Ultra-widefield (UWF) fundus image; FOV: 200 degrees; 1924 by 1556 pixels:
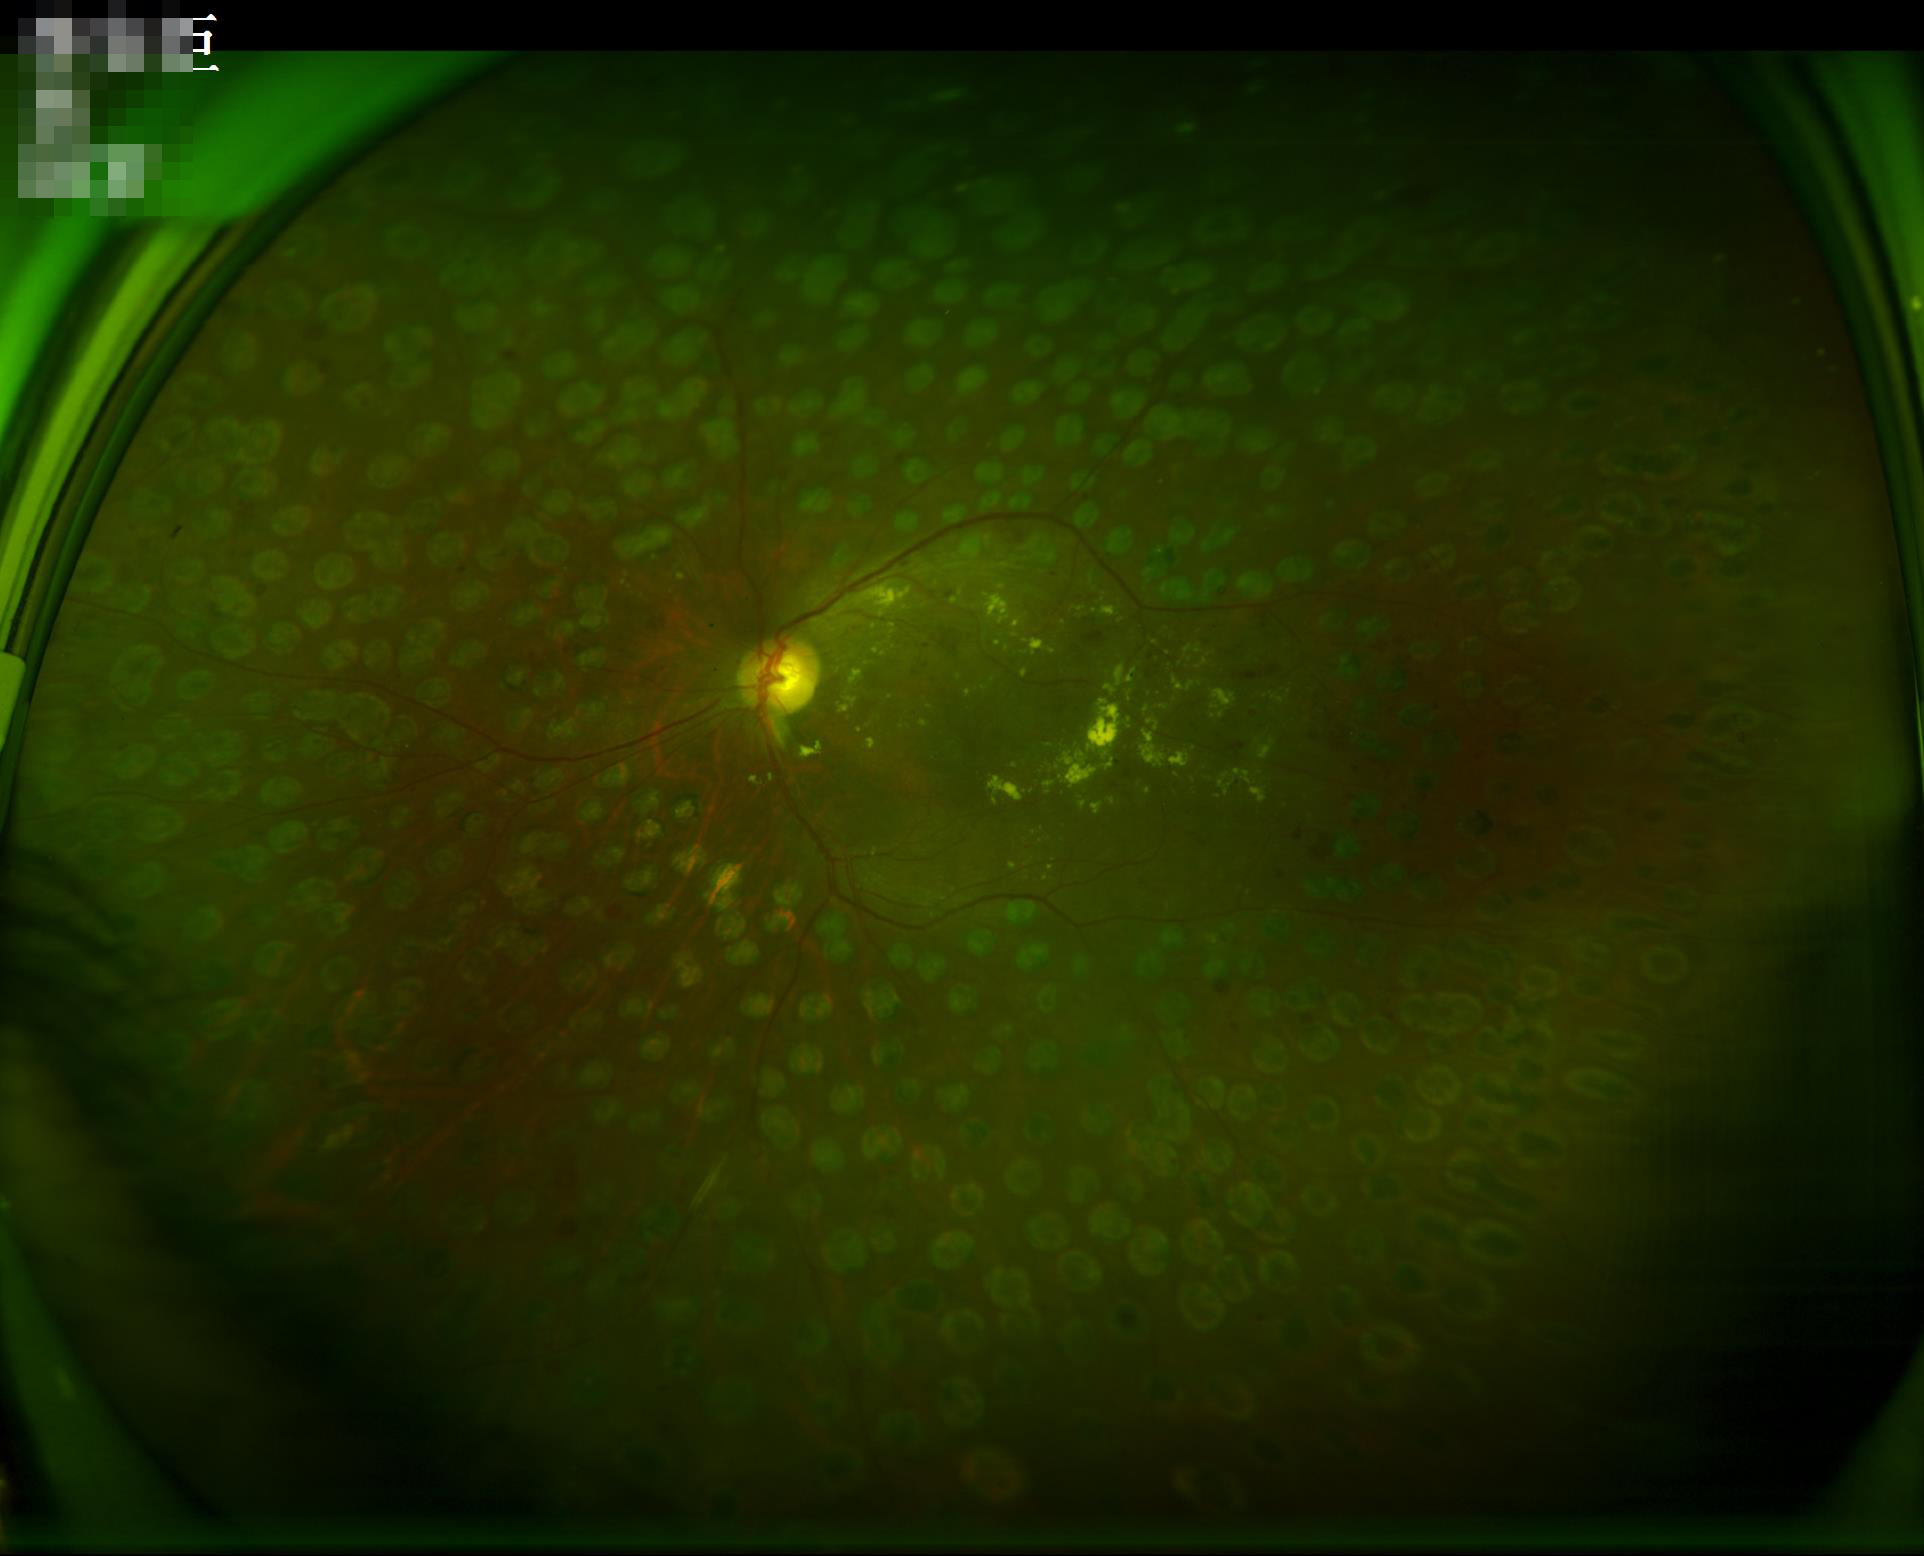 {
  "illumination": "uneven",
  "overall_quality": "good",
  "contrast": "good"
}